848 x 848 pixels. Posterior pole color fundus photograph
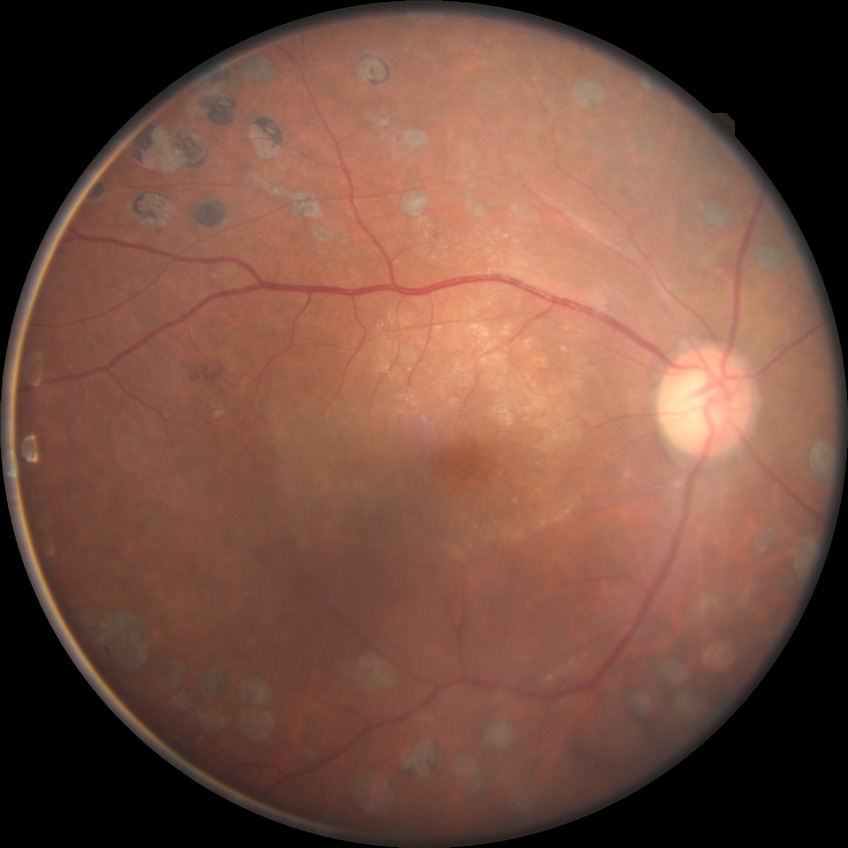
Diabetic retinopathy stage: proliferative diabetic retinopathy.